Posterior pole photograph
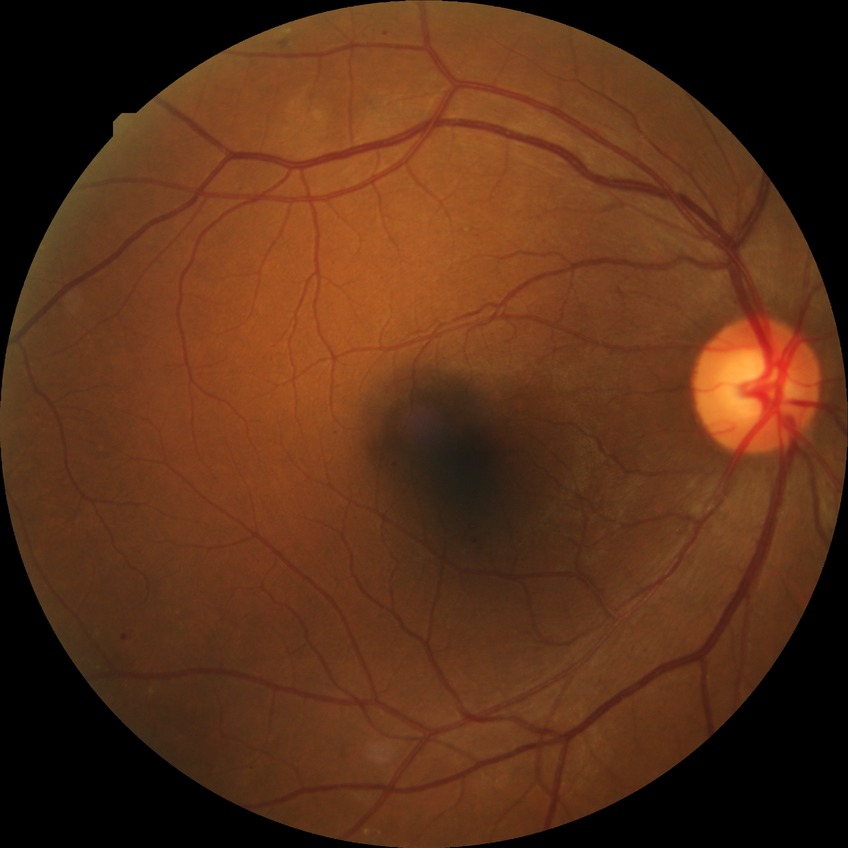 {"proliferative_class": "non-proliferative diabetic retinopathy", "davis_grade": "simple diabetic retinopathy"}